1240x1240 · wide-field fundus photograph from neonatal ROP screening.
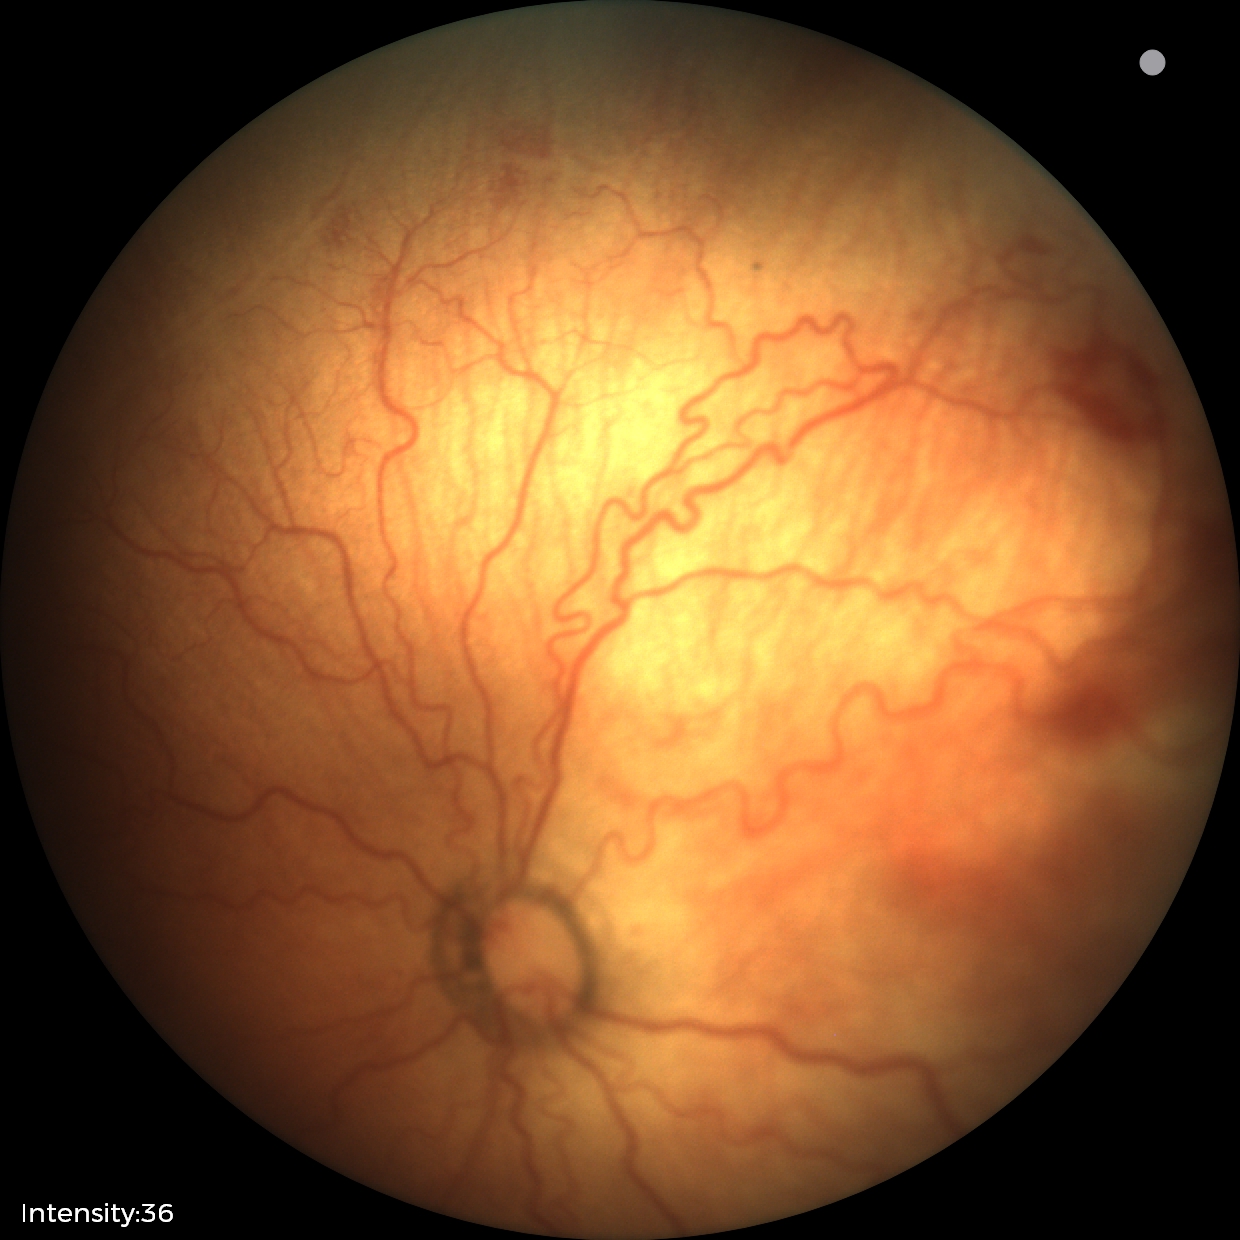 Assessment: plus disease; retinopathy of prematurity (ROP) stage 2.